Acquired with a Nidek AFC-330.
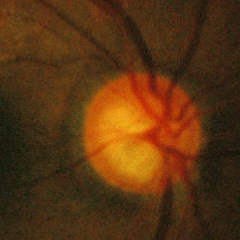
There is evidence of early glaucoma.